Fundus photo · no pharmacologic dilation · 848x848
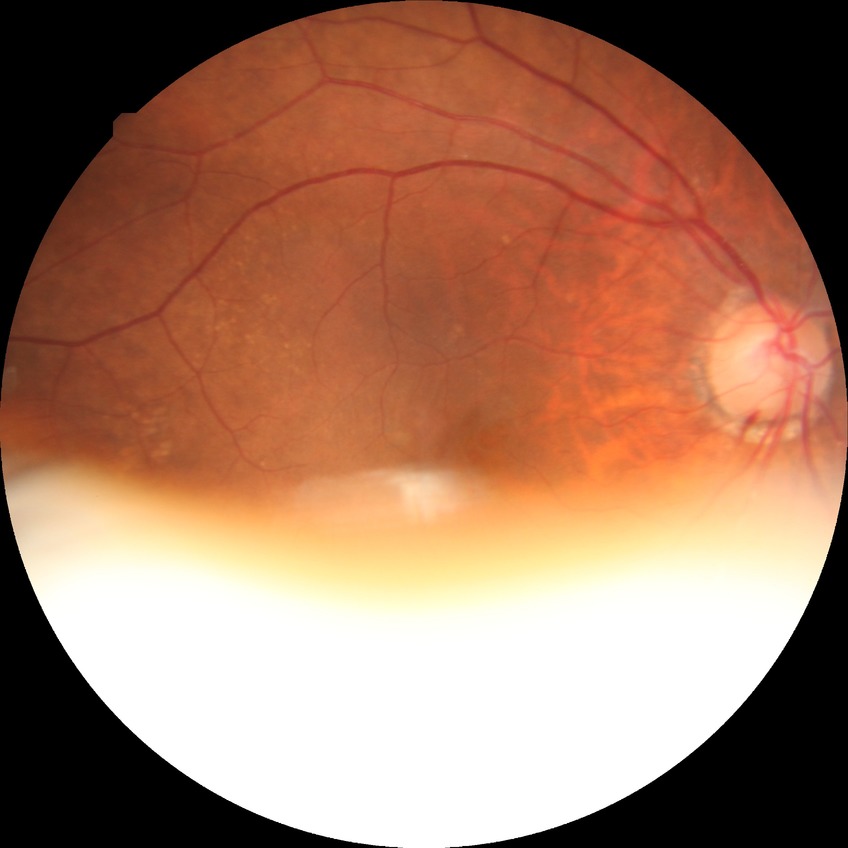

Diabetic retinopathy (DR): no diabetic retinopathy (NDR).